Dilated-pupil acquisition — 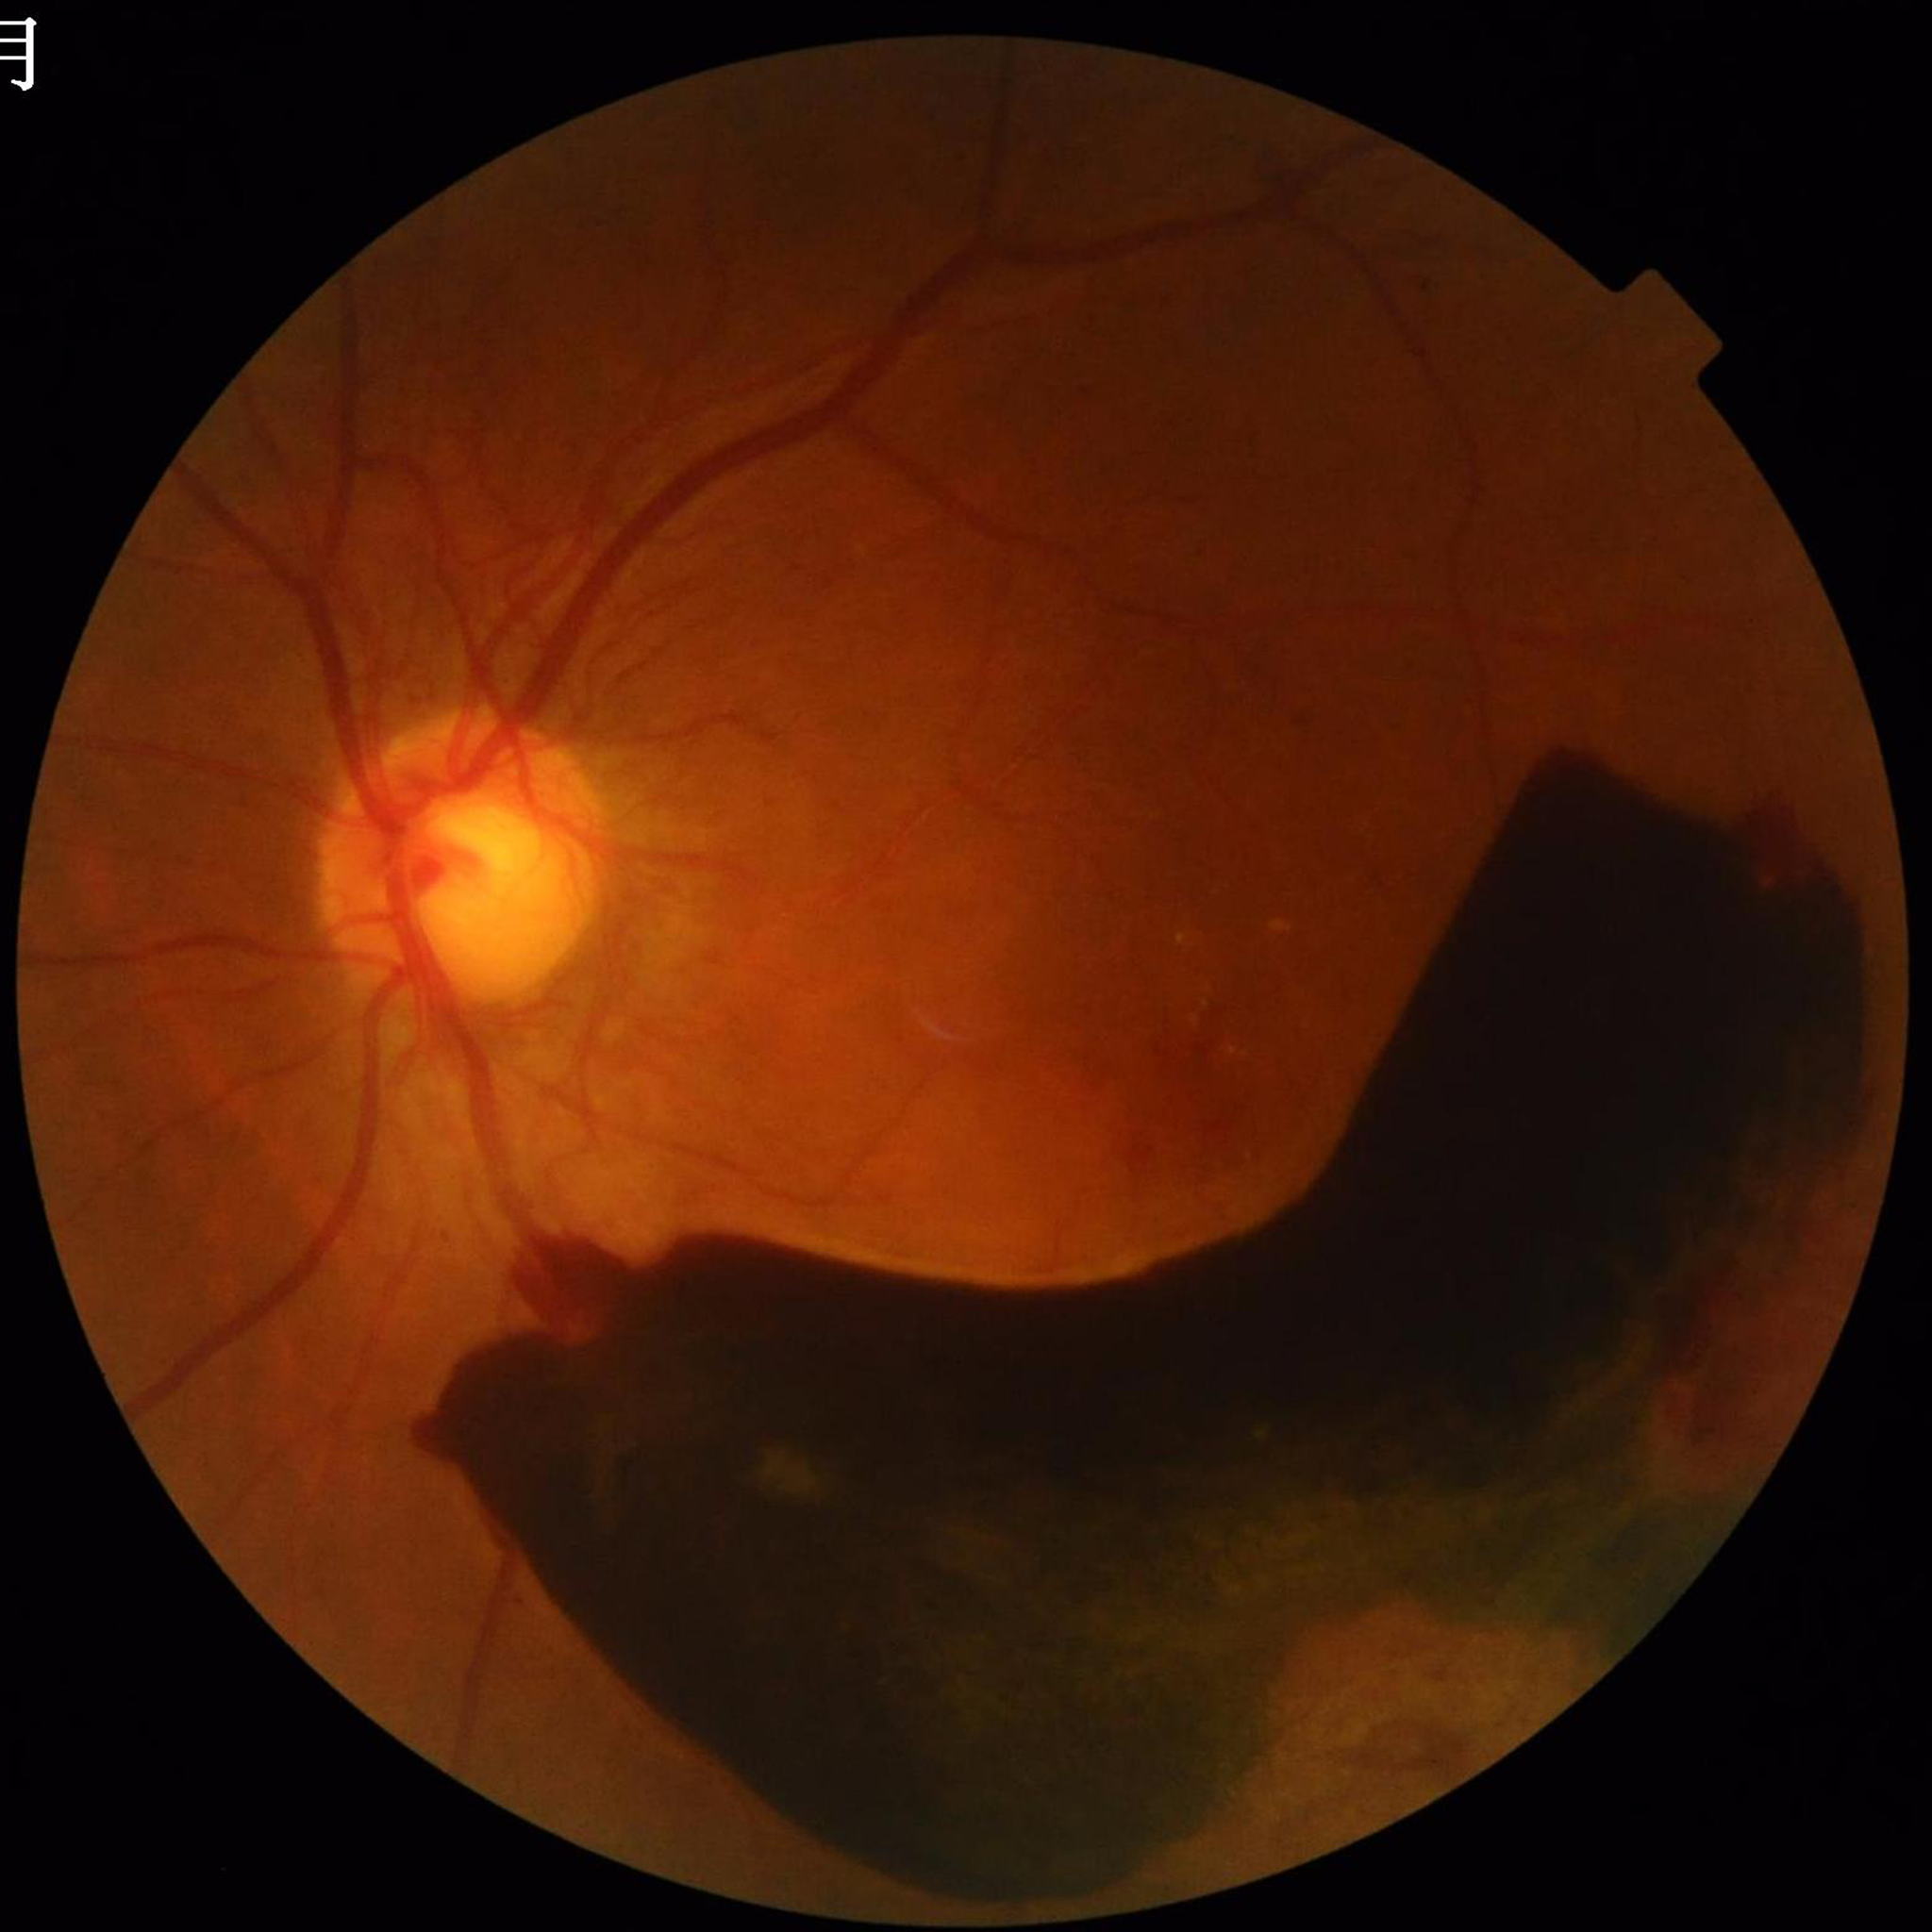

Disease = diabetic retinopathy
Quality = illumination and color satisfactory, blur present, contrast adequate